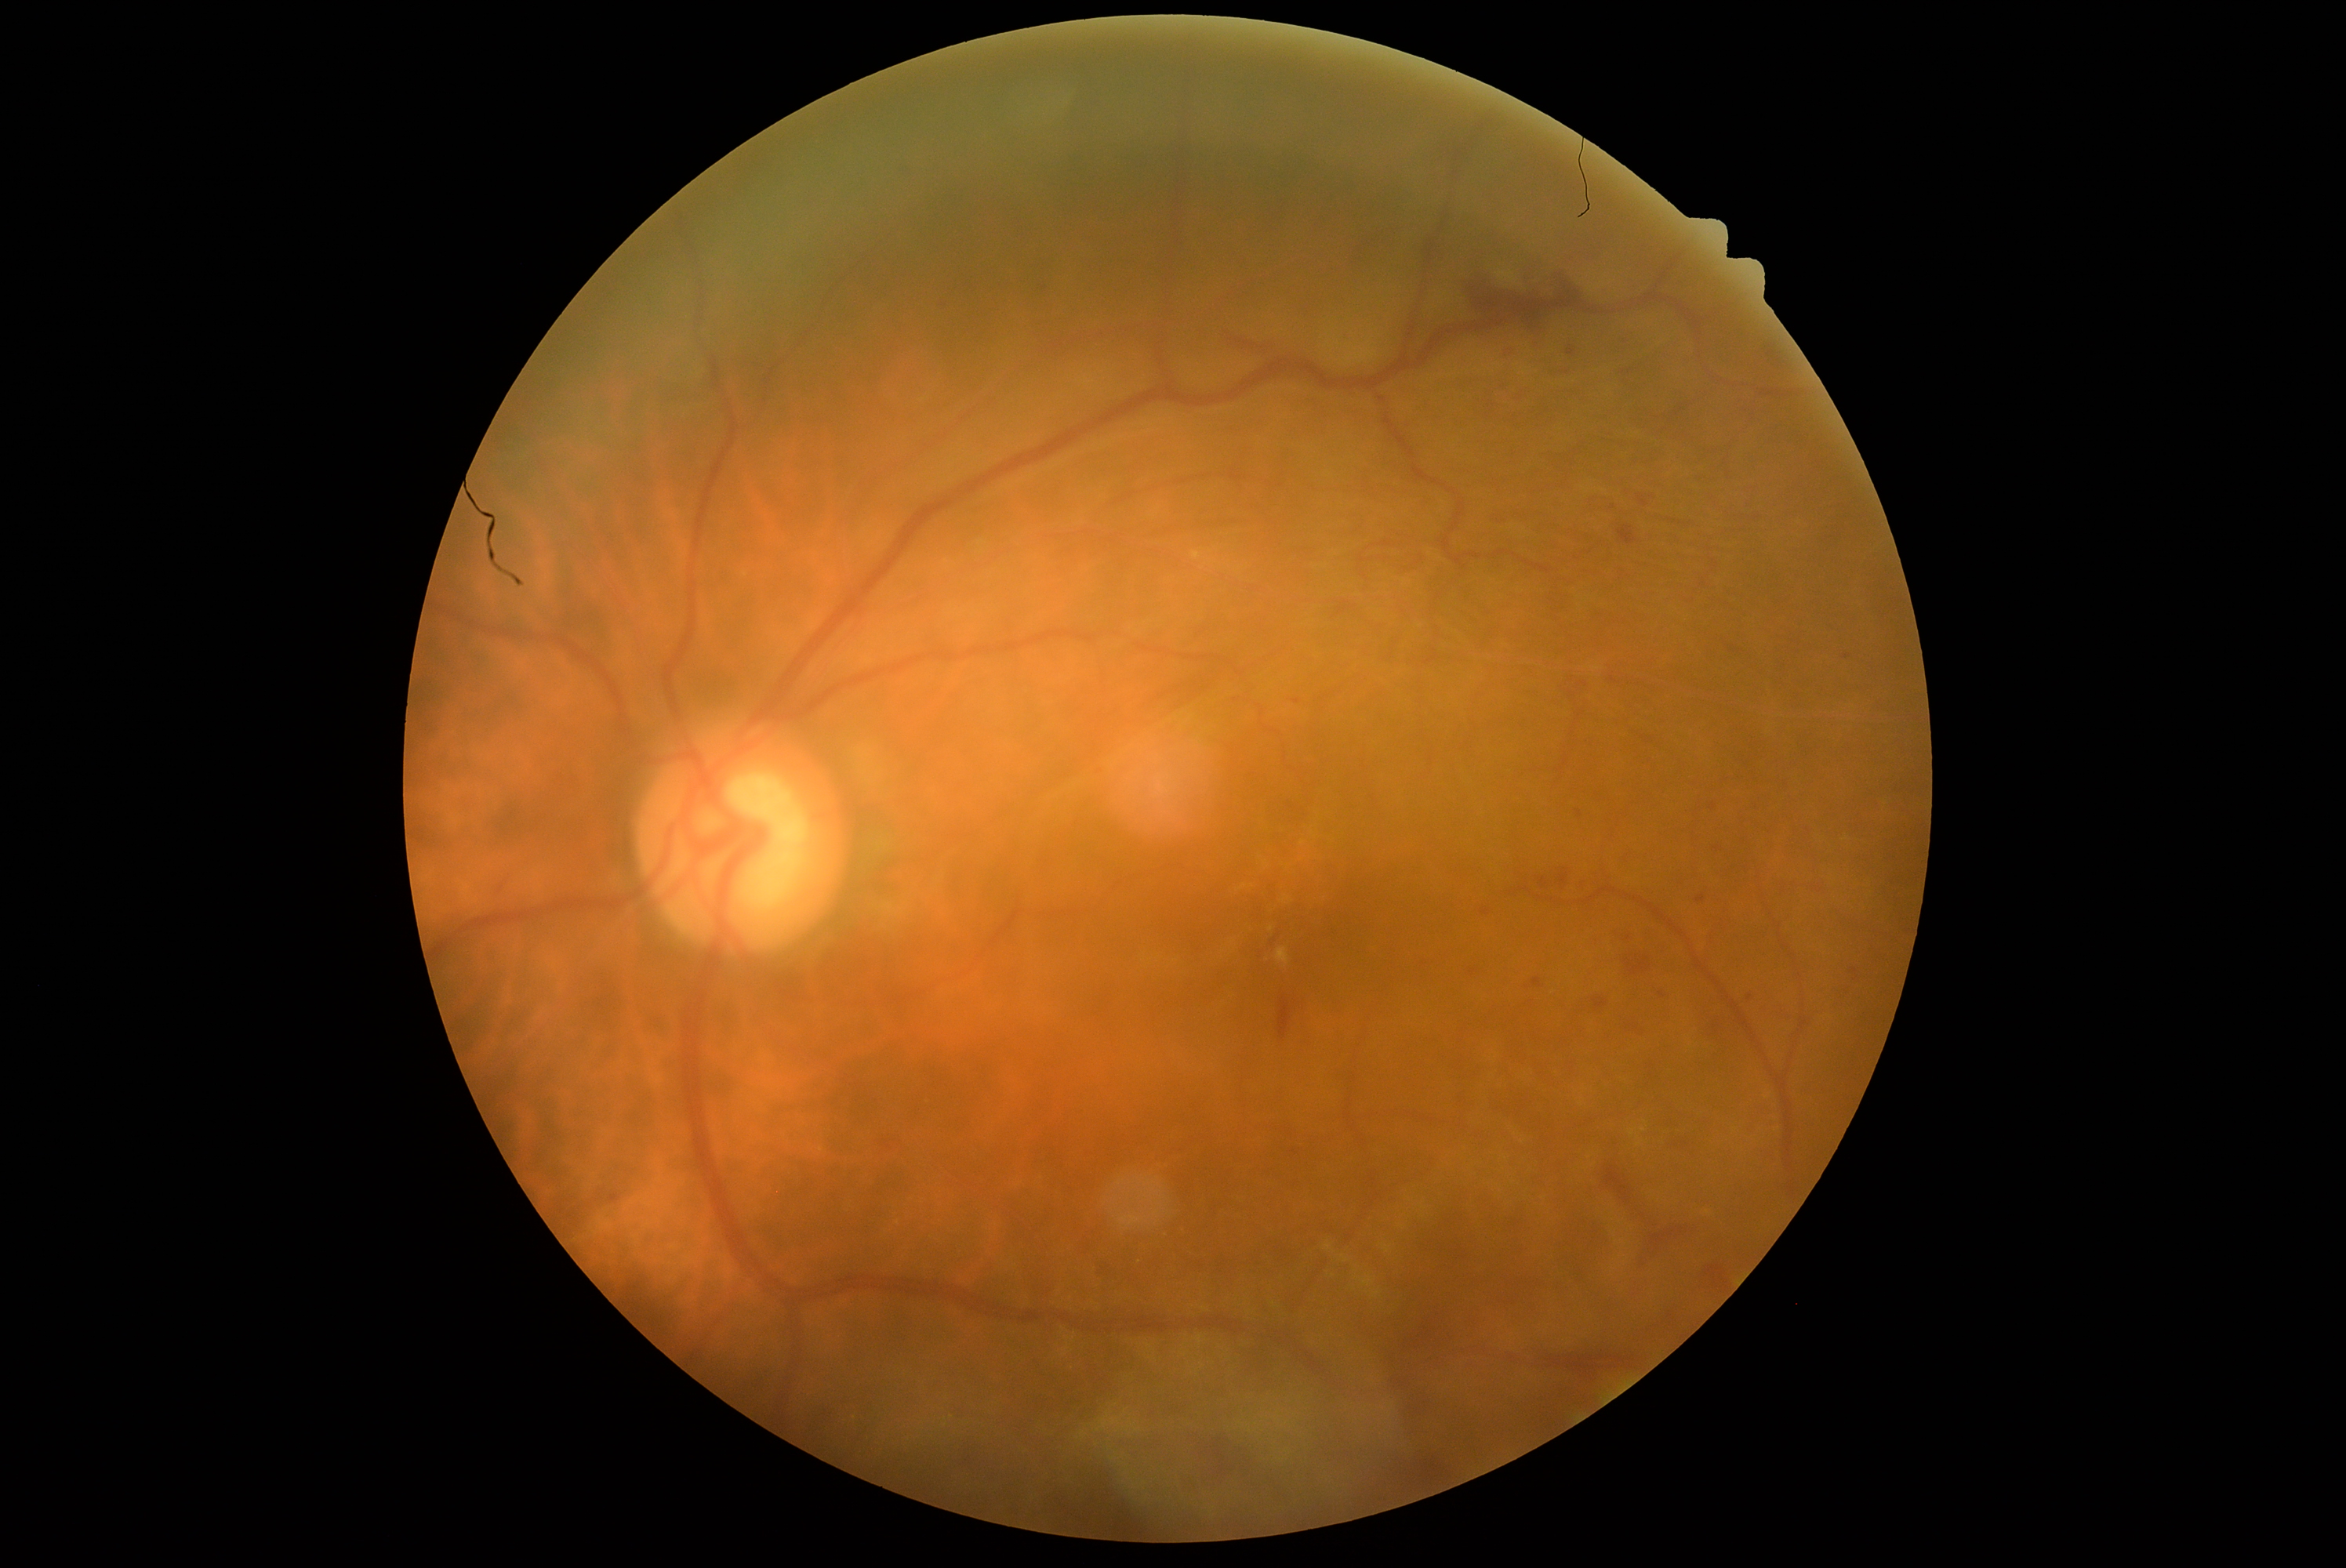
Retinopathy is moderate NPDR (grade 2)
Lesions identified (partial list):
hemorrhages (partial) = Rect(934, 297, 953, 314) | Rect(1594, 998, 1608, 1009) | Rect(1599, 1164, 1709, 1272) | Rect(1743, 992, 1759, 1004) | Rect(611, 1196, 620, 1203) | Rect(1632, 490, 1657, 510) | Rect(1586, 498, 1622, 515) | Rect(1723, 644, 1752, 664) | Rect(1621, 953, 1657, 979) | Rect(1509, 387, 1530, 405) | Rect(1698, 1257, 1735, 1291)
Small hemorrhages approximately at x=1717, y=849 | x=1580, y=814 | x=1473, y=972